Ultra-widefield (UWF) fundus image
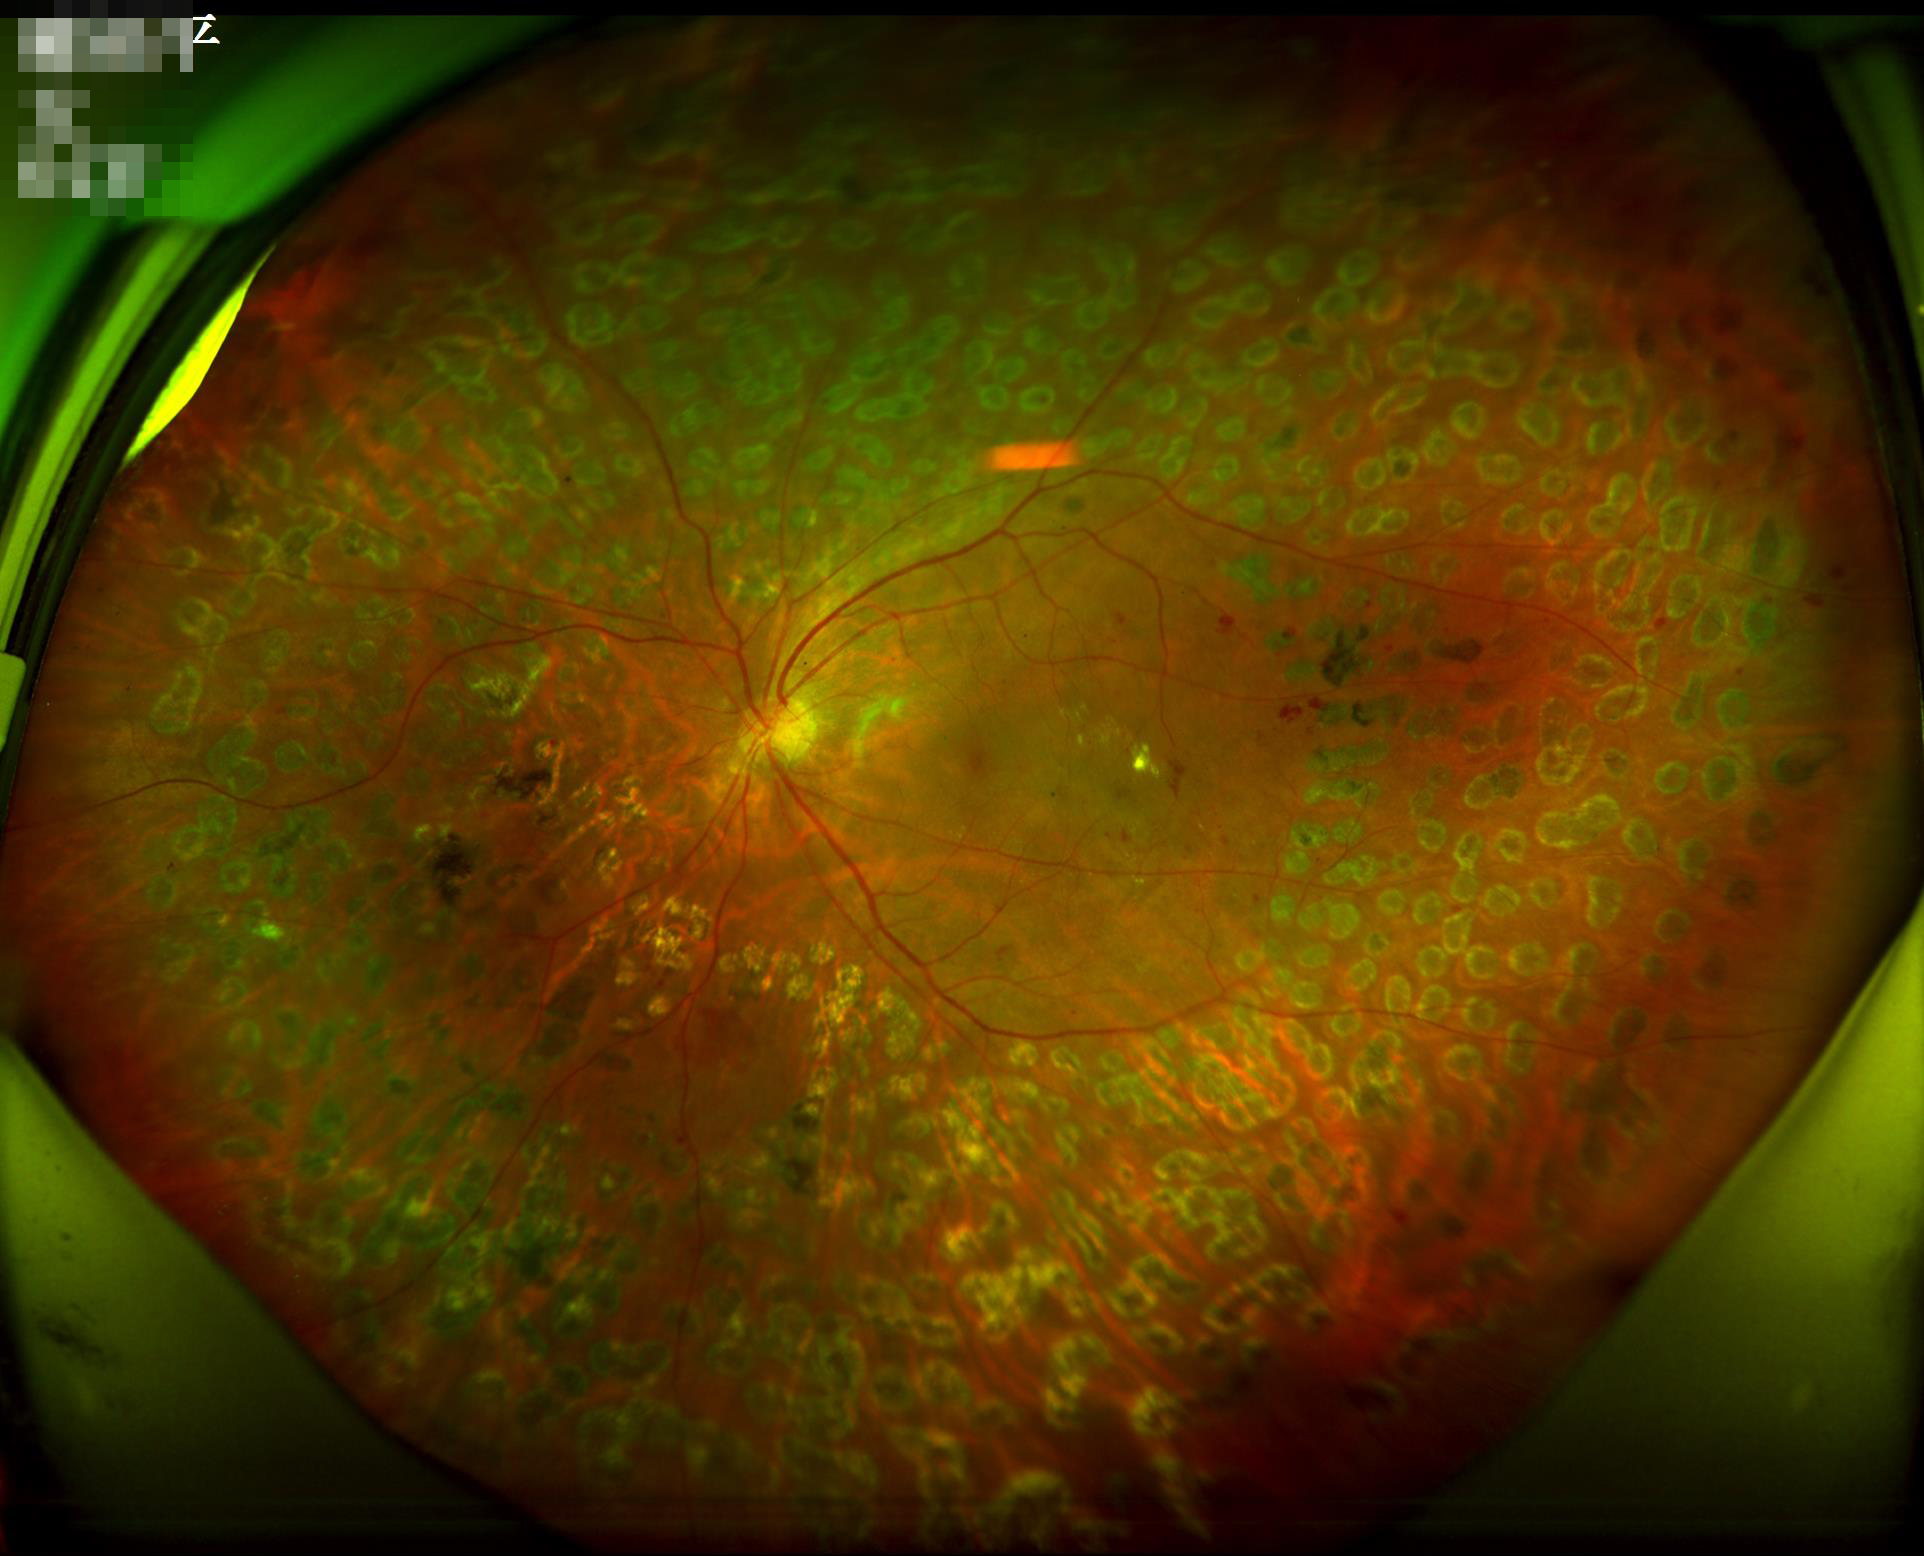 Even illumination with no color cast.
Good dynamic range.
Overall image quality is good.
No noticeable blur.